Captured with the Clarity RetCam 3 (130° field of view); pediatric retinal photograph (wide-field)
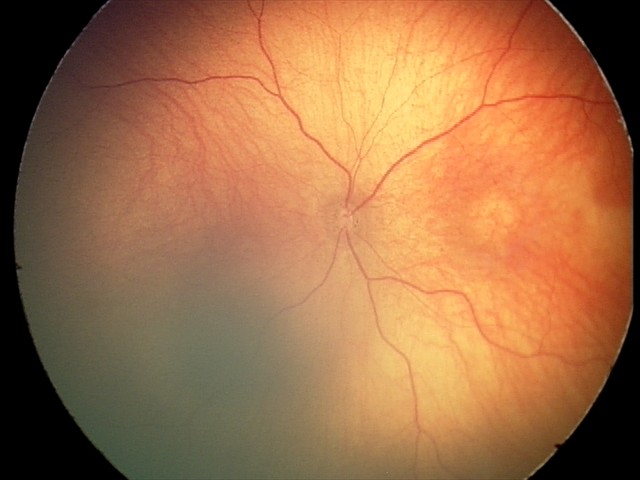

Screening examination diagnosed as physiological.